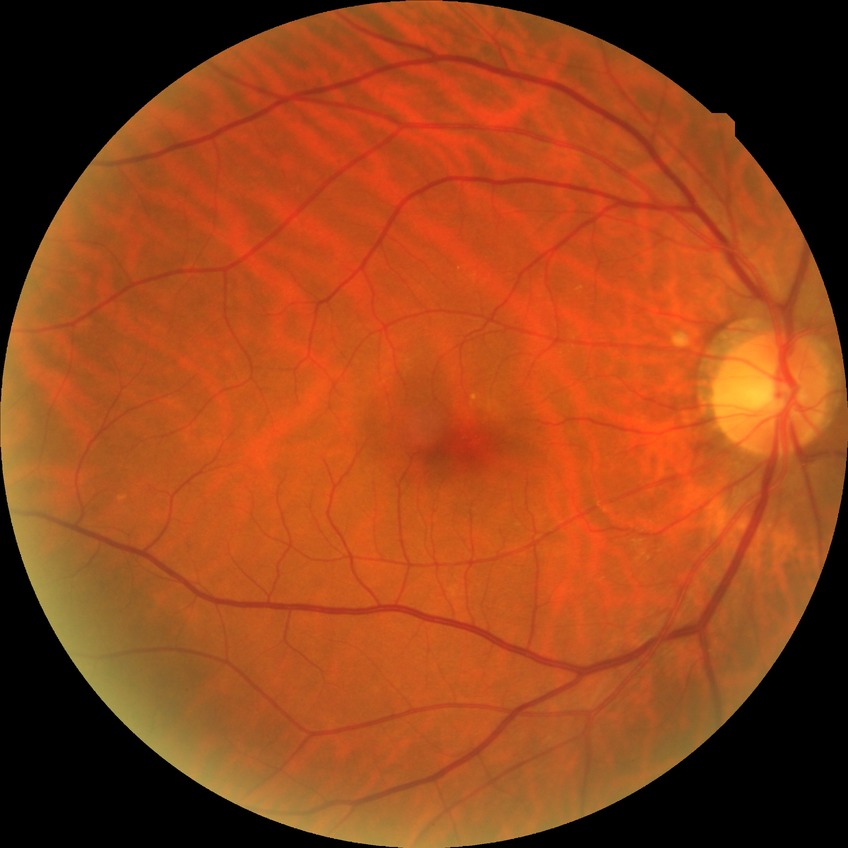

diabetic retinopathy (DR): no diabetic retinopathy (NDR).